45° FOV · CFP
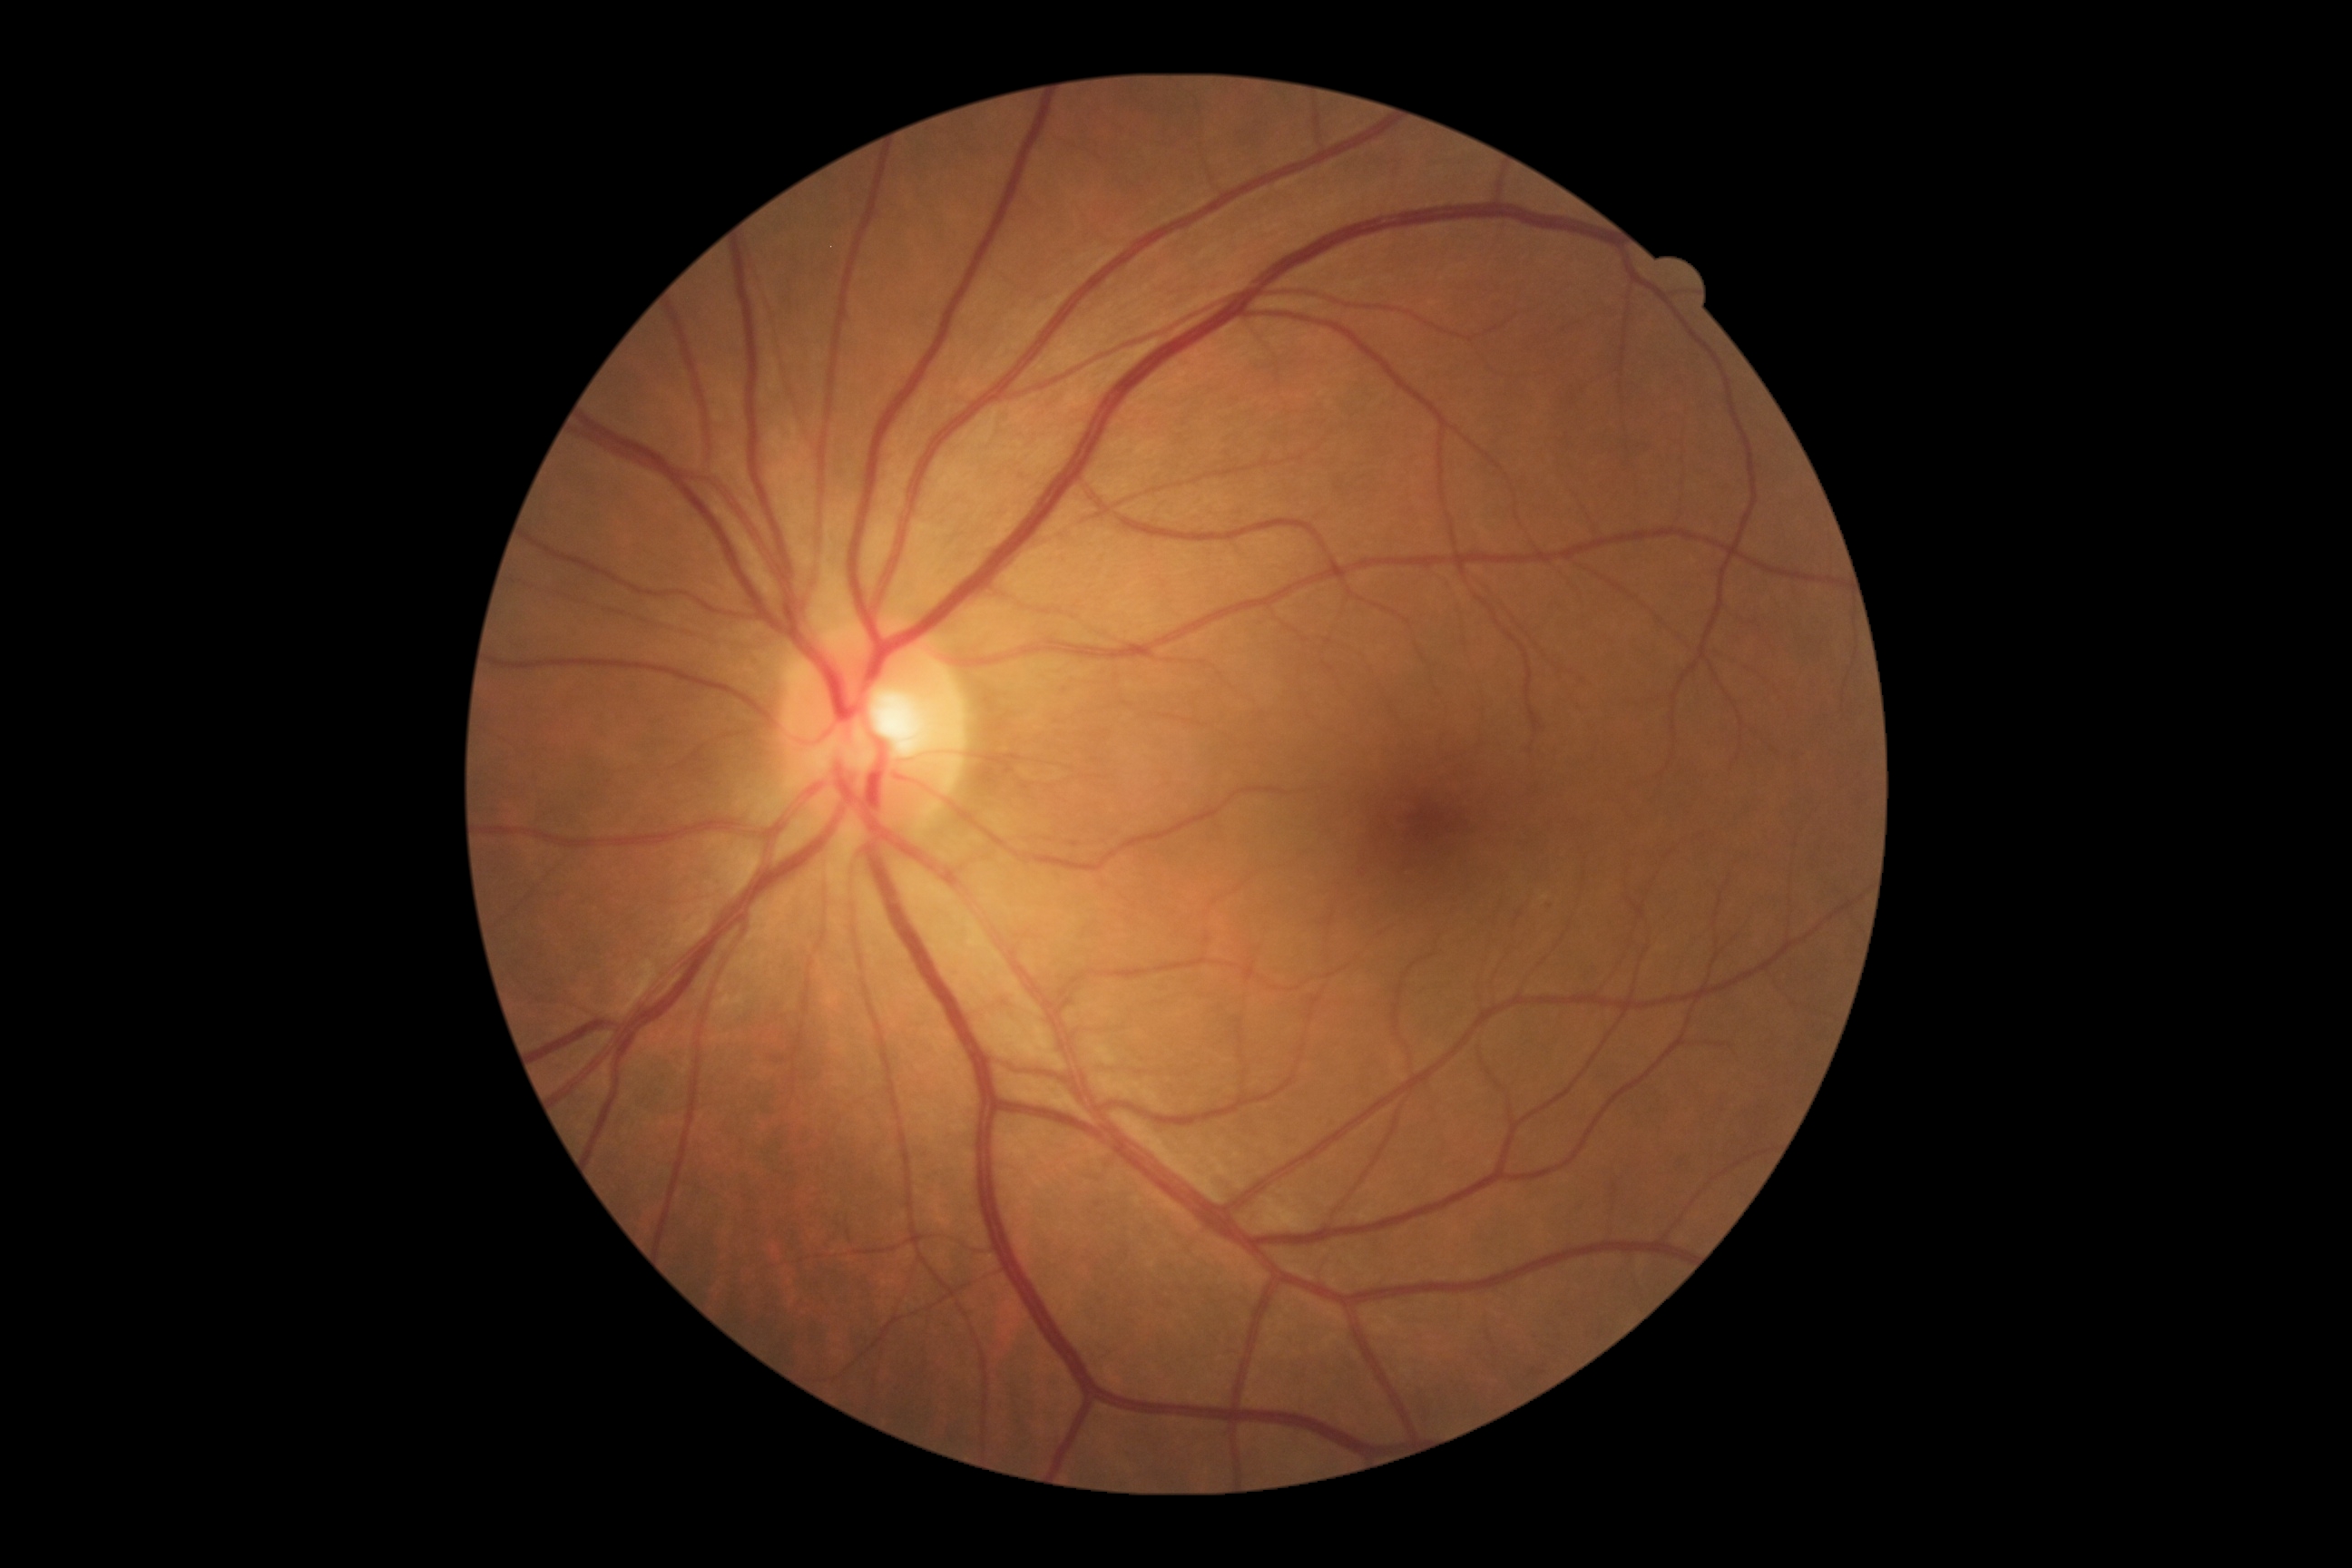 DR stage is mild non-proliferative diabetic retinopathy (grade 1).